CFP.
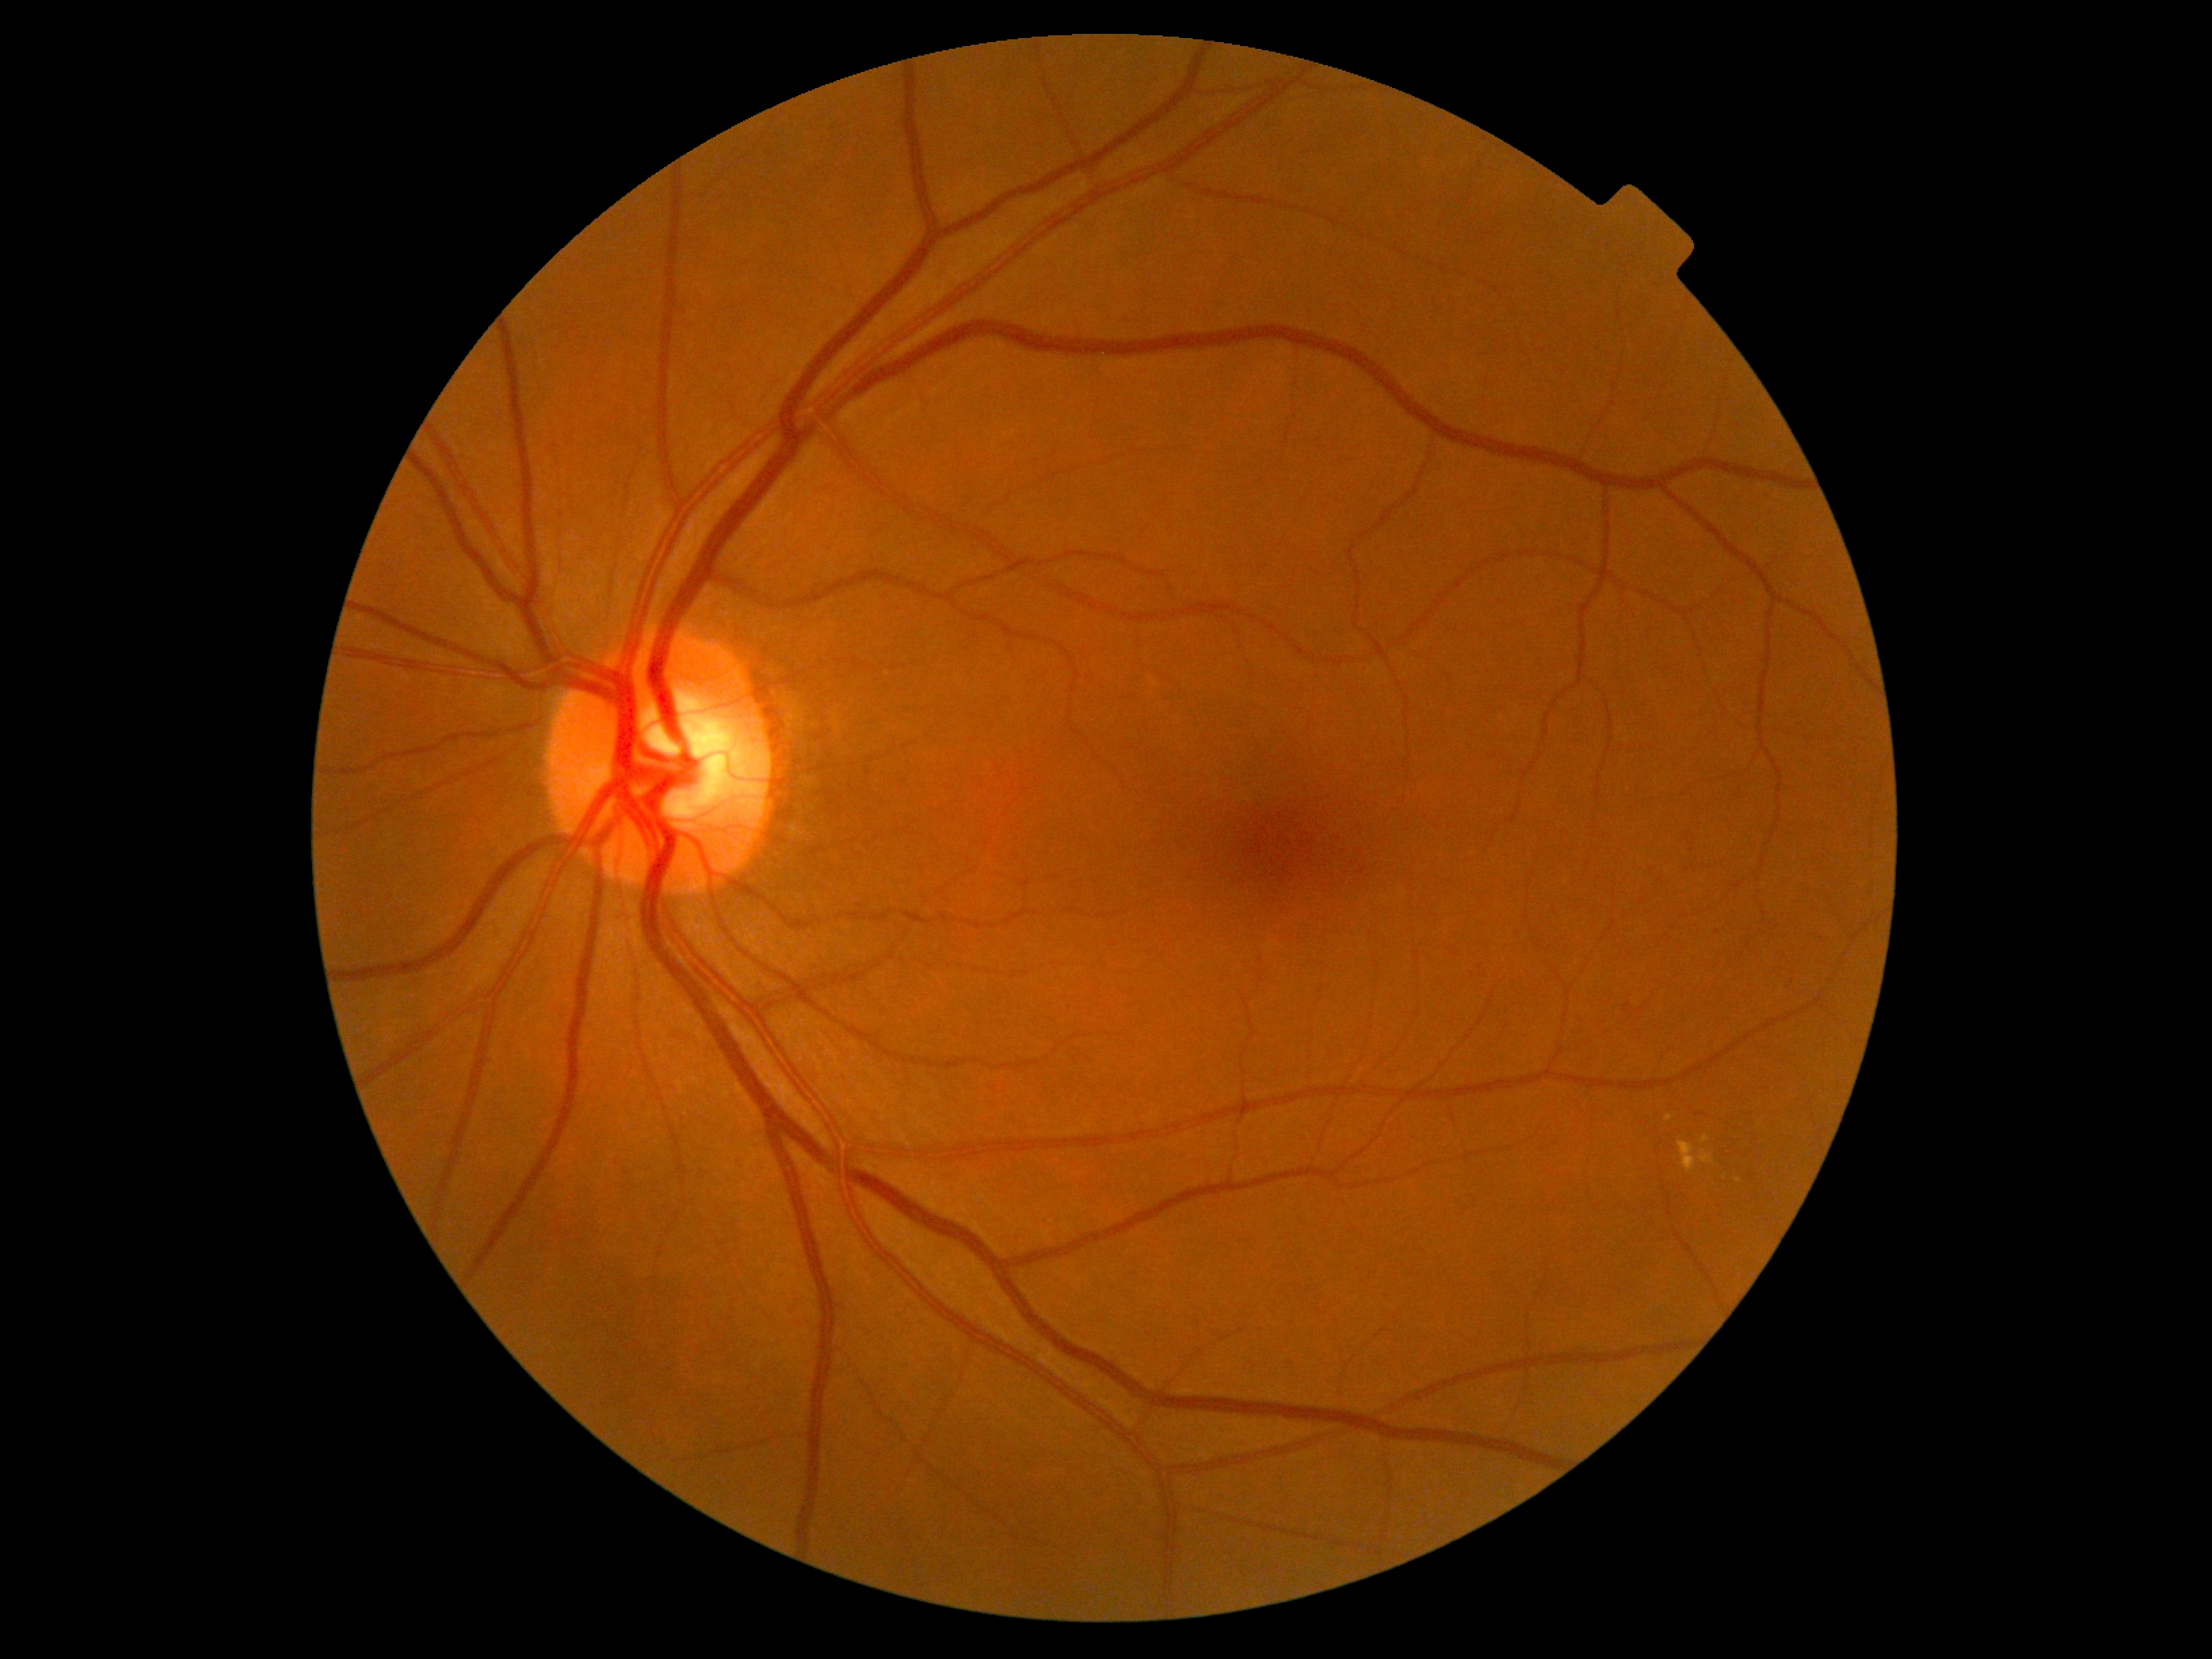
DR severity is moderate non-proliferative diabetic retinopathy (grade 2) — more than just microaneurysms but less than severe NPDR.